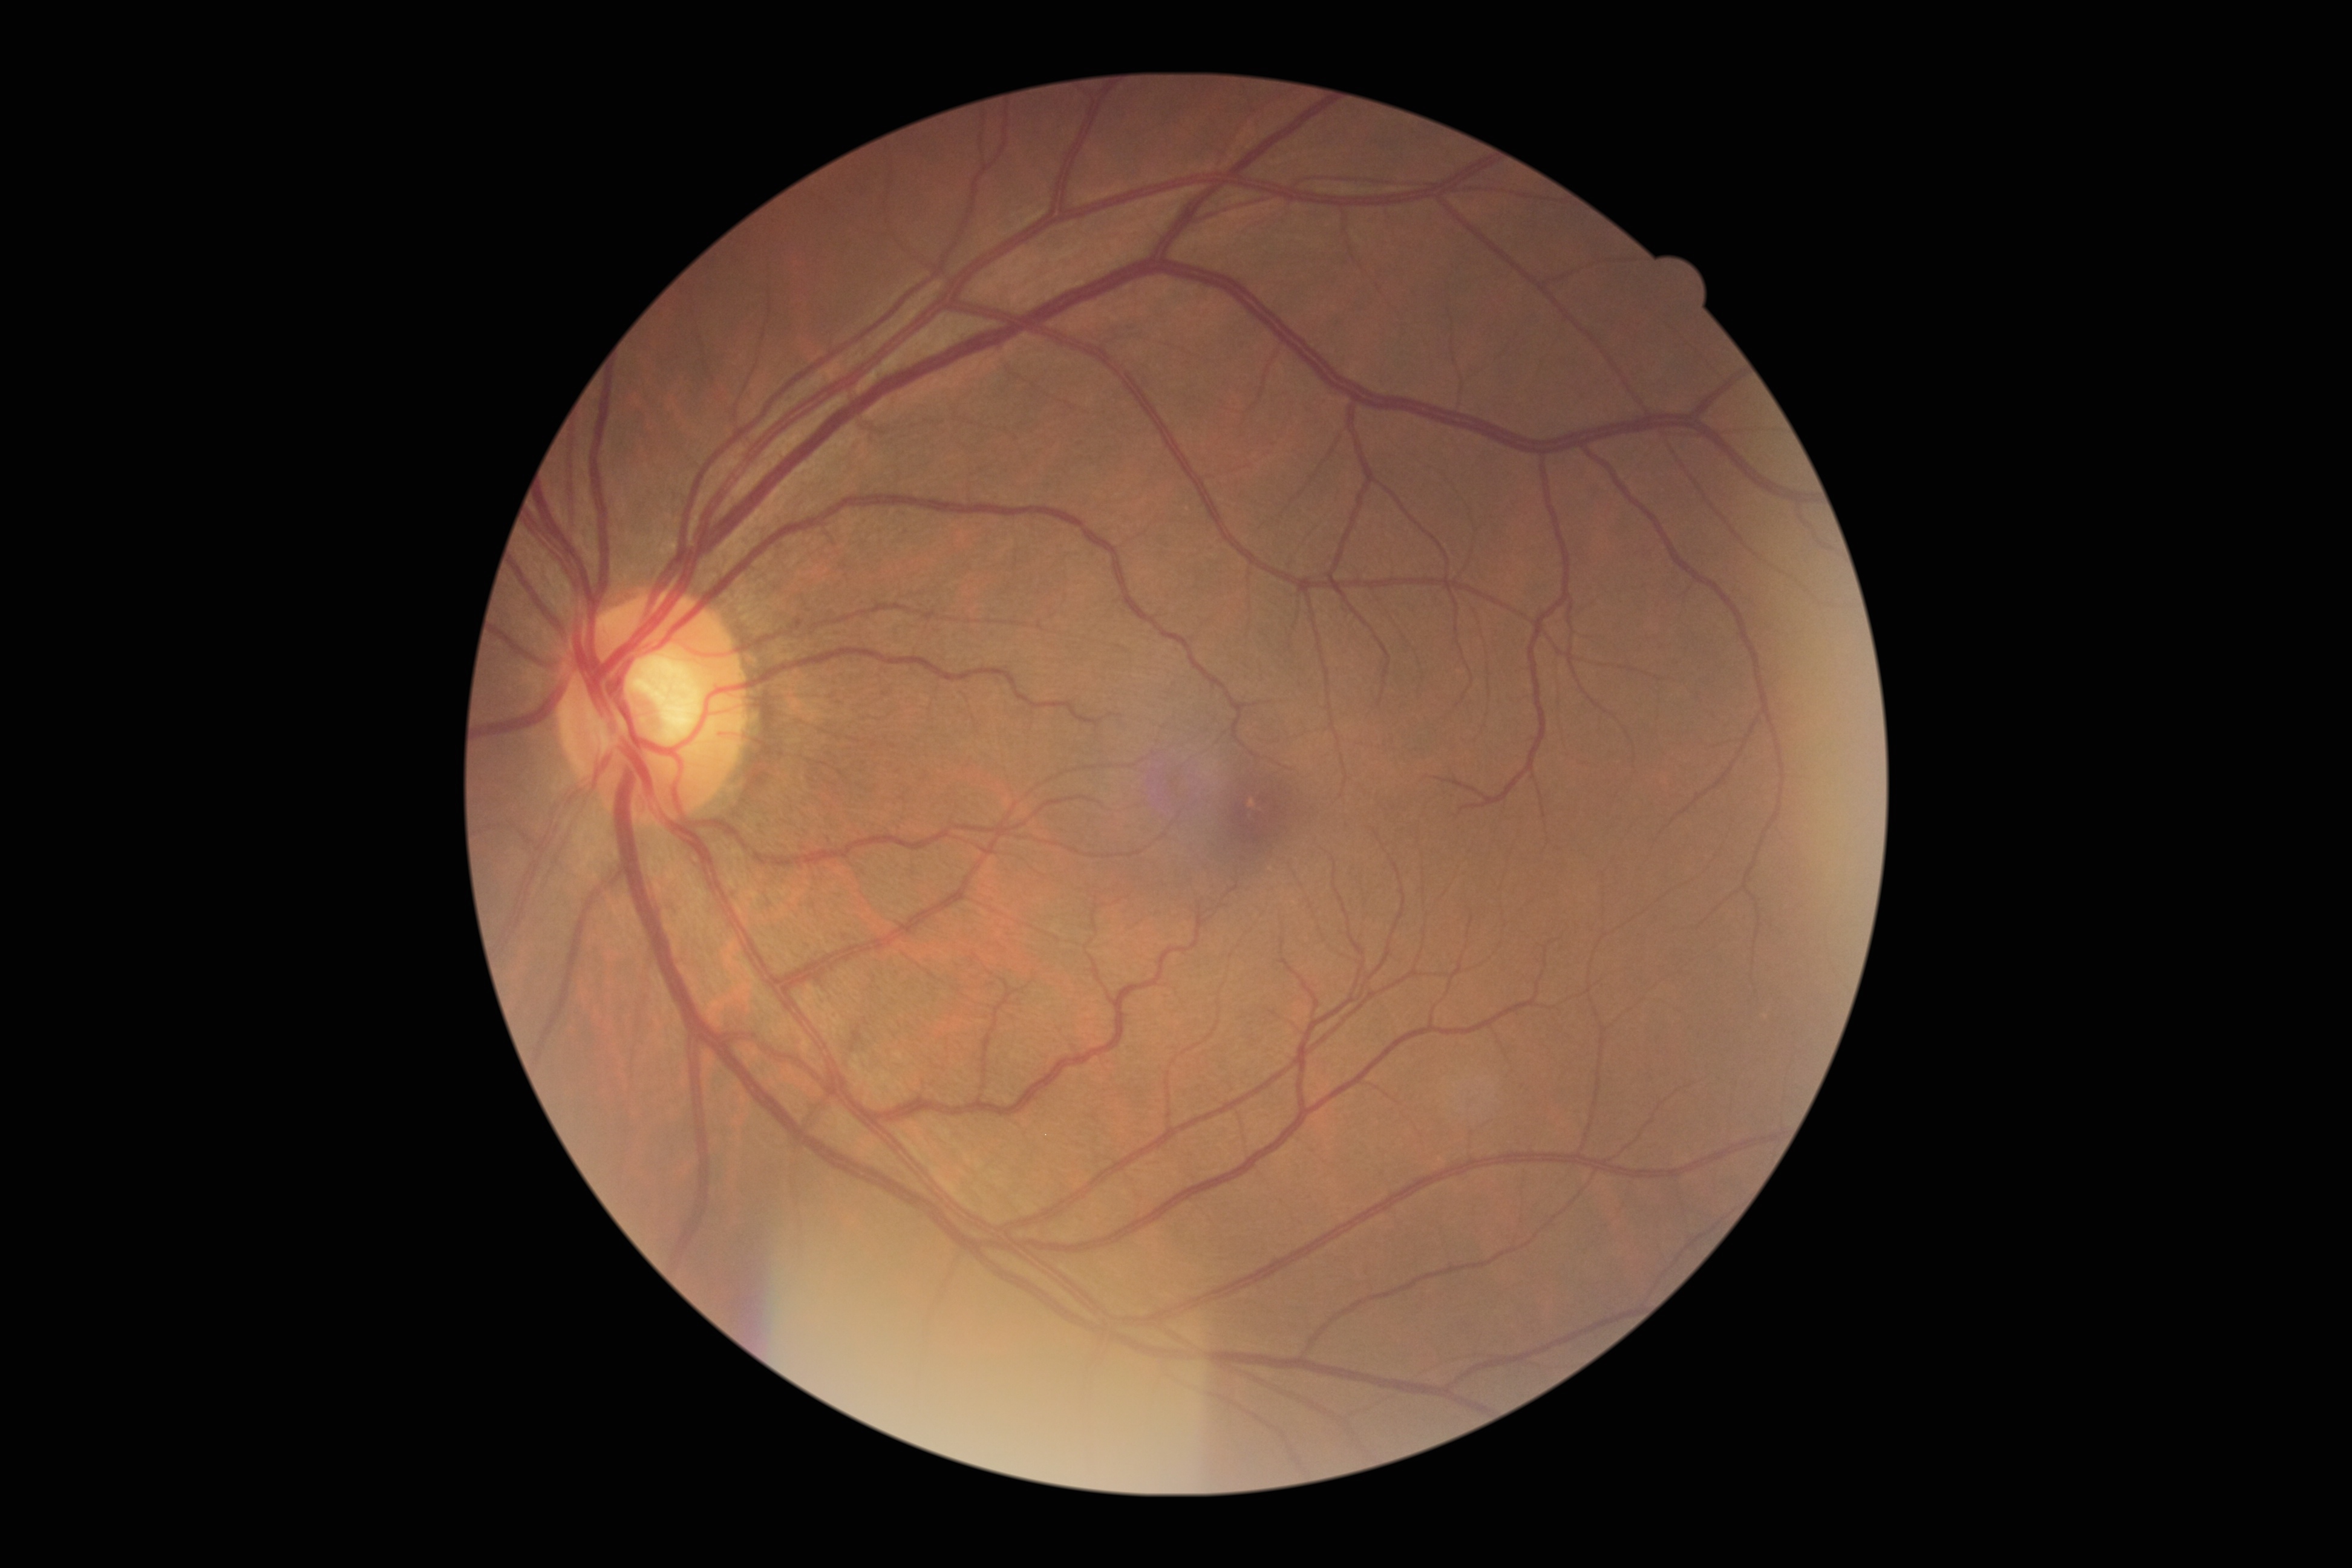
DR: no apparent retinopathy (grade 0). No apparent diabetic retinopathy.